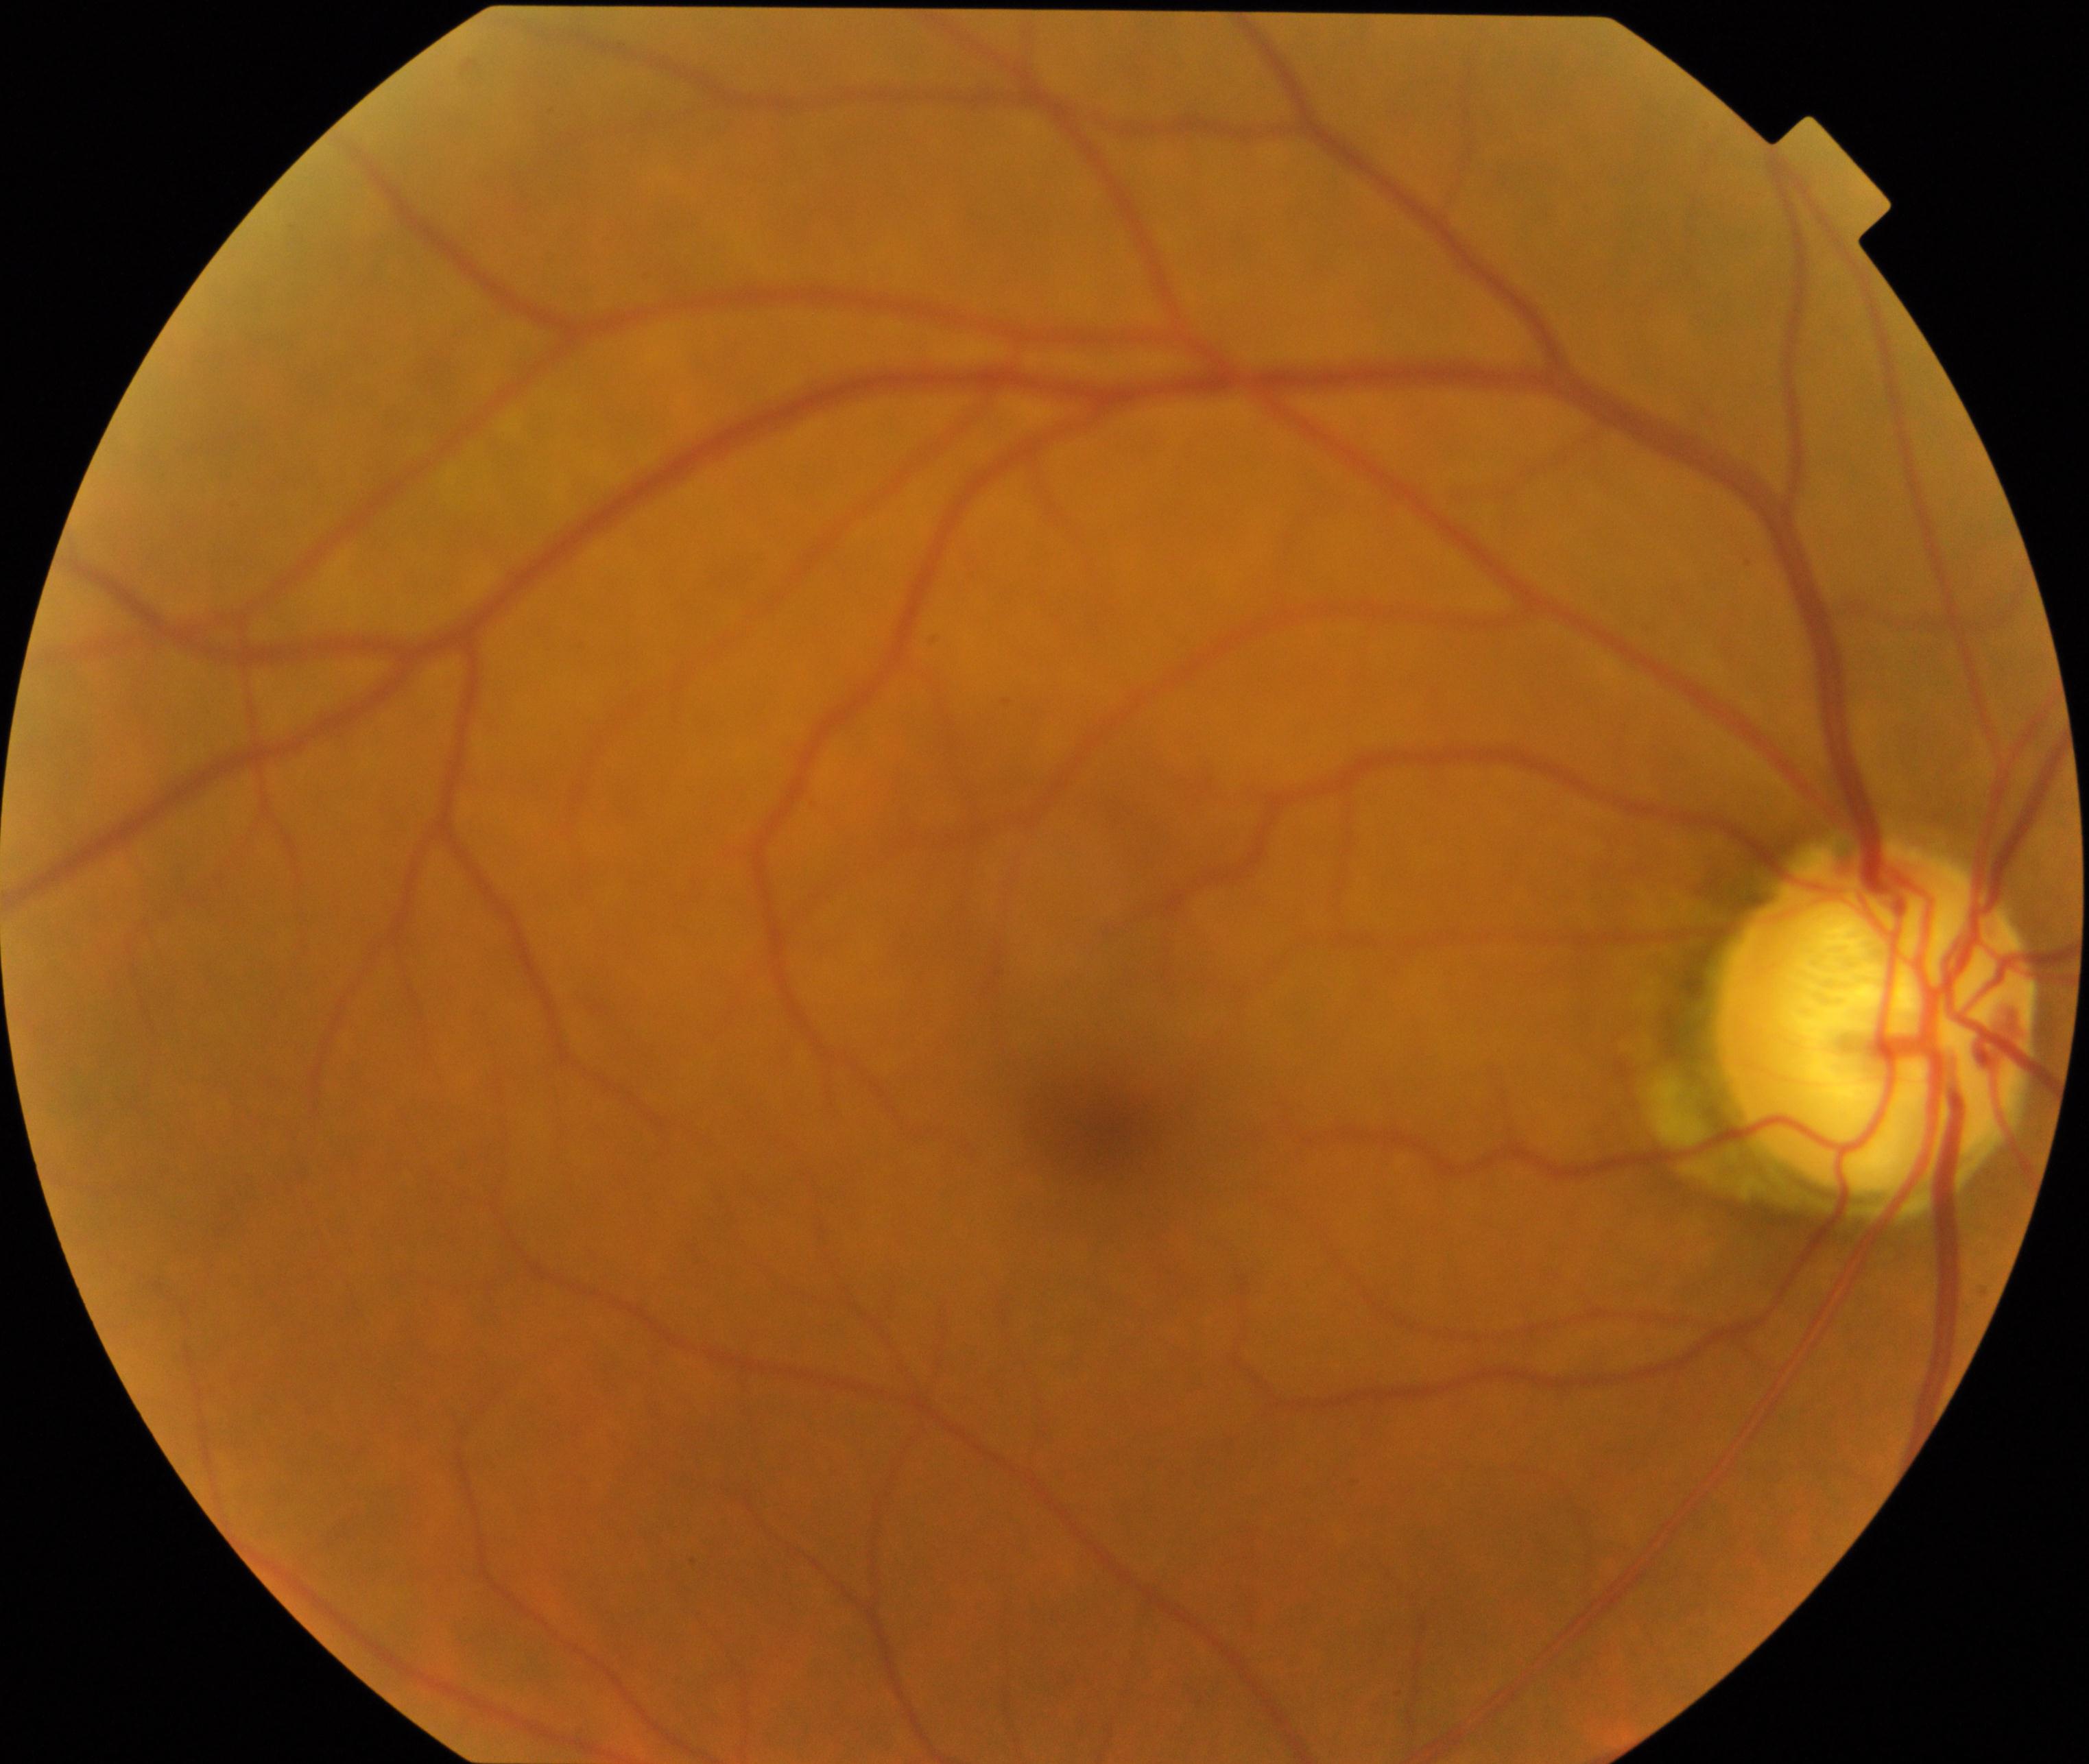

Diagnosis: possible glaucoma.